DR severity per modified Davis staging. Without pupil dilation — 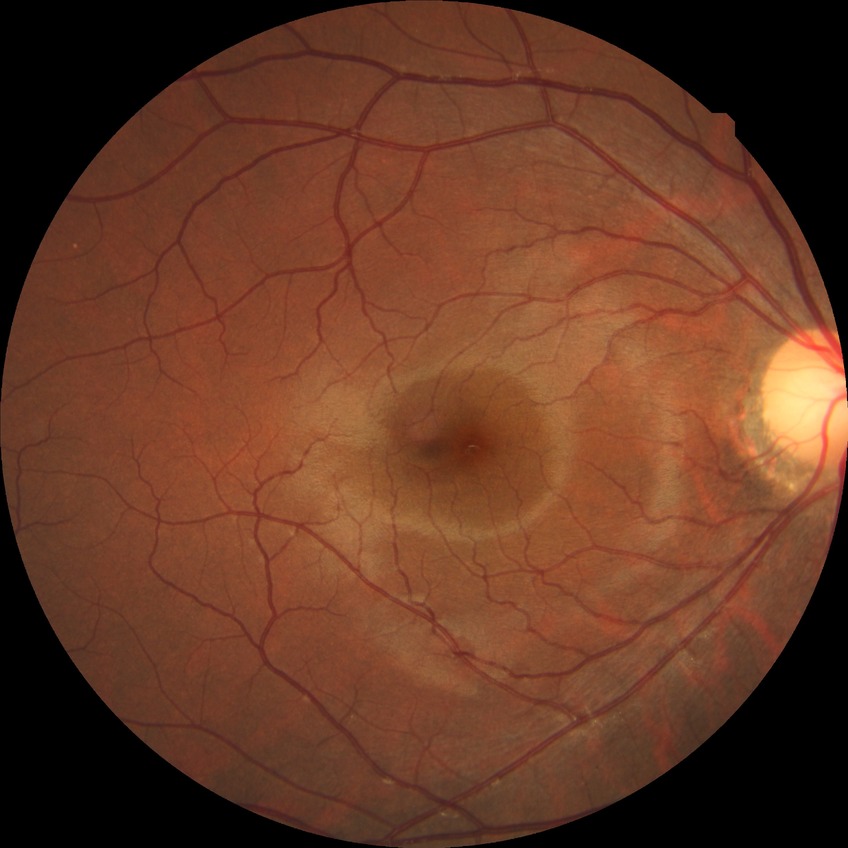

DR impression@no signs of DR; Davis grade@NDR.